Posterior pole field covering the optic disc and macula; 50° FOV — 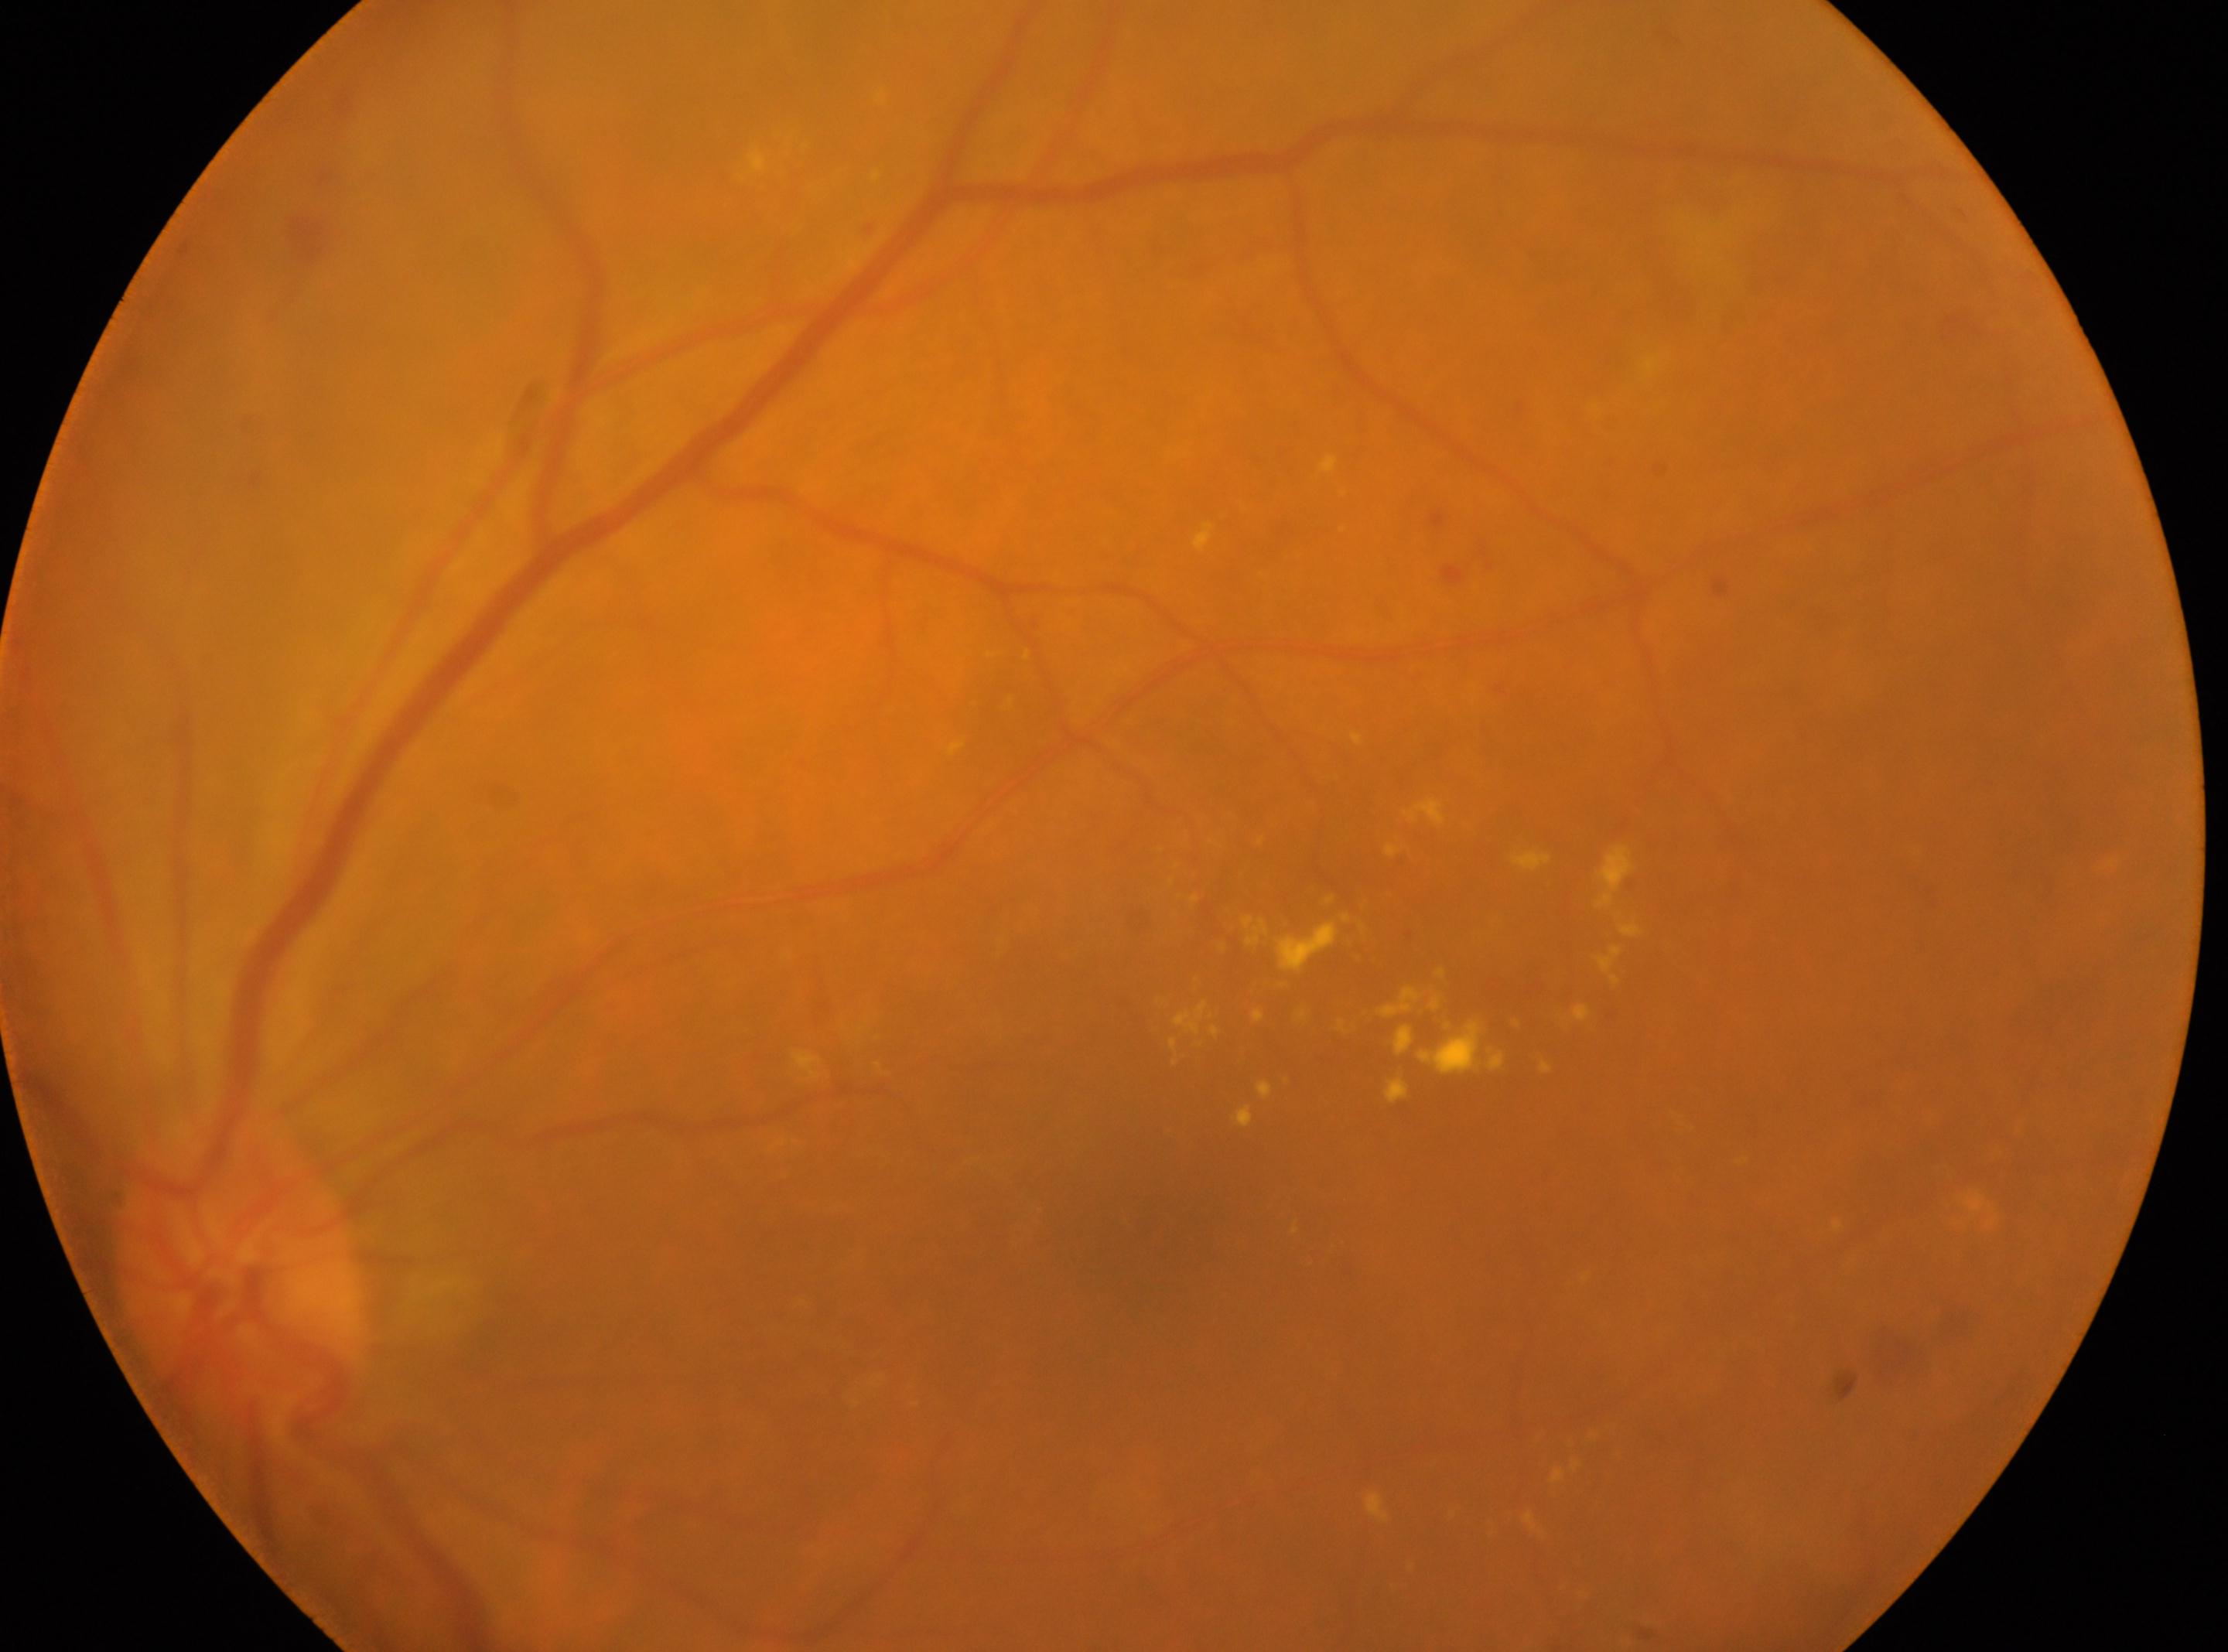
DR class: non-proliferative diabetic retinopathy. The fovea is at 1143, 1227. Imaged eye: left eye. Diabetic retinopathy (DR) is grade 2. The ONH is at 241, 1276.